CFP: 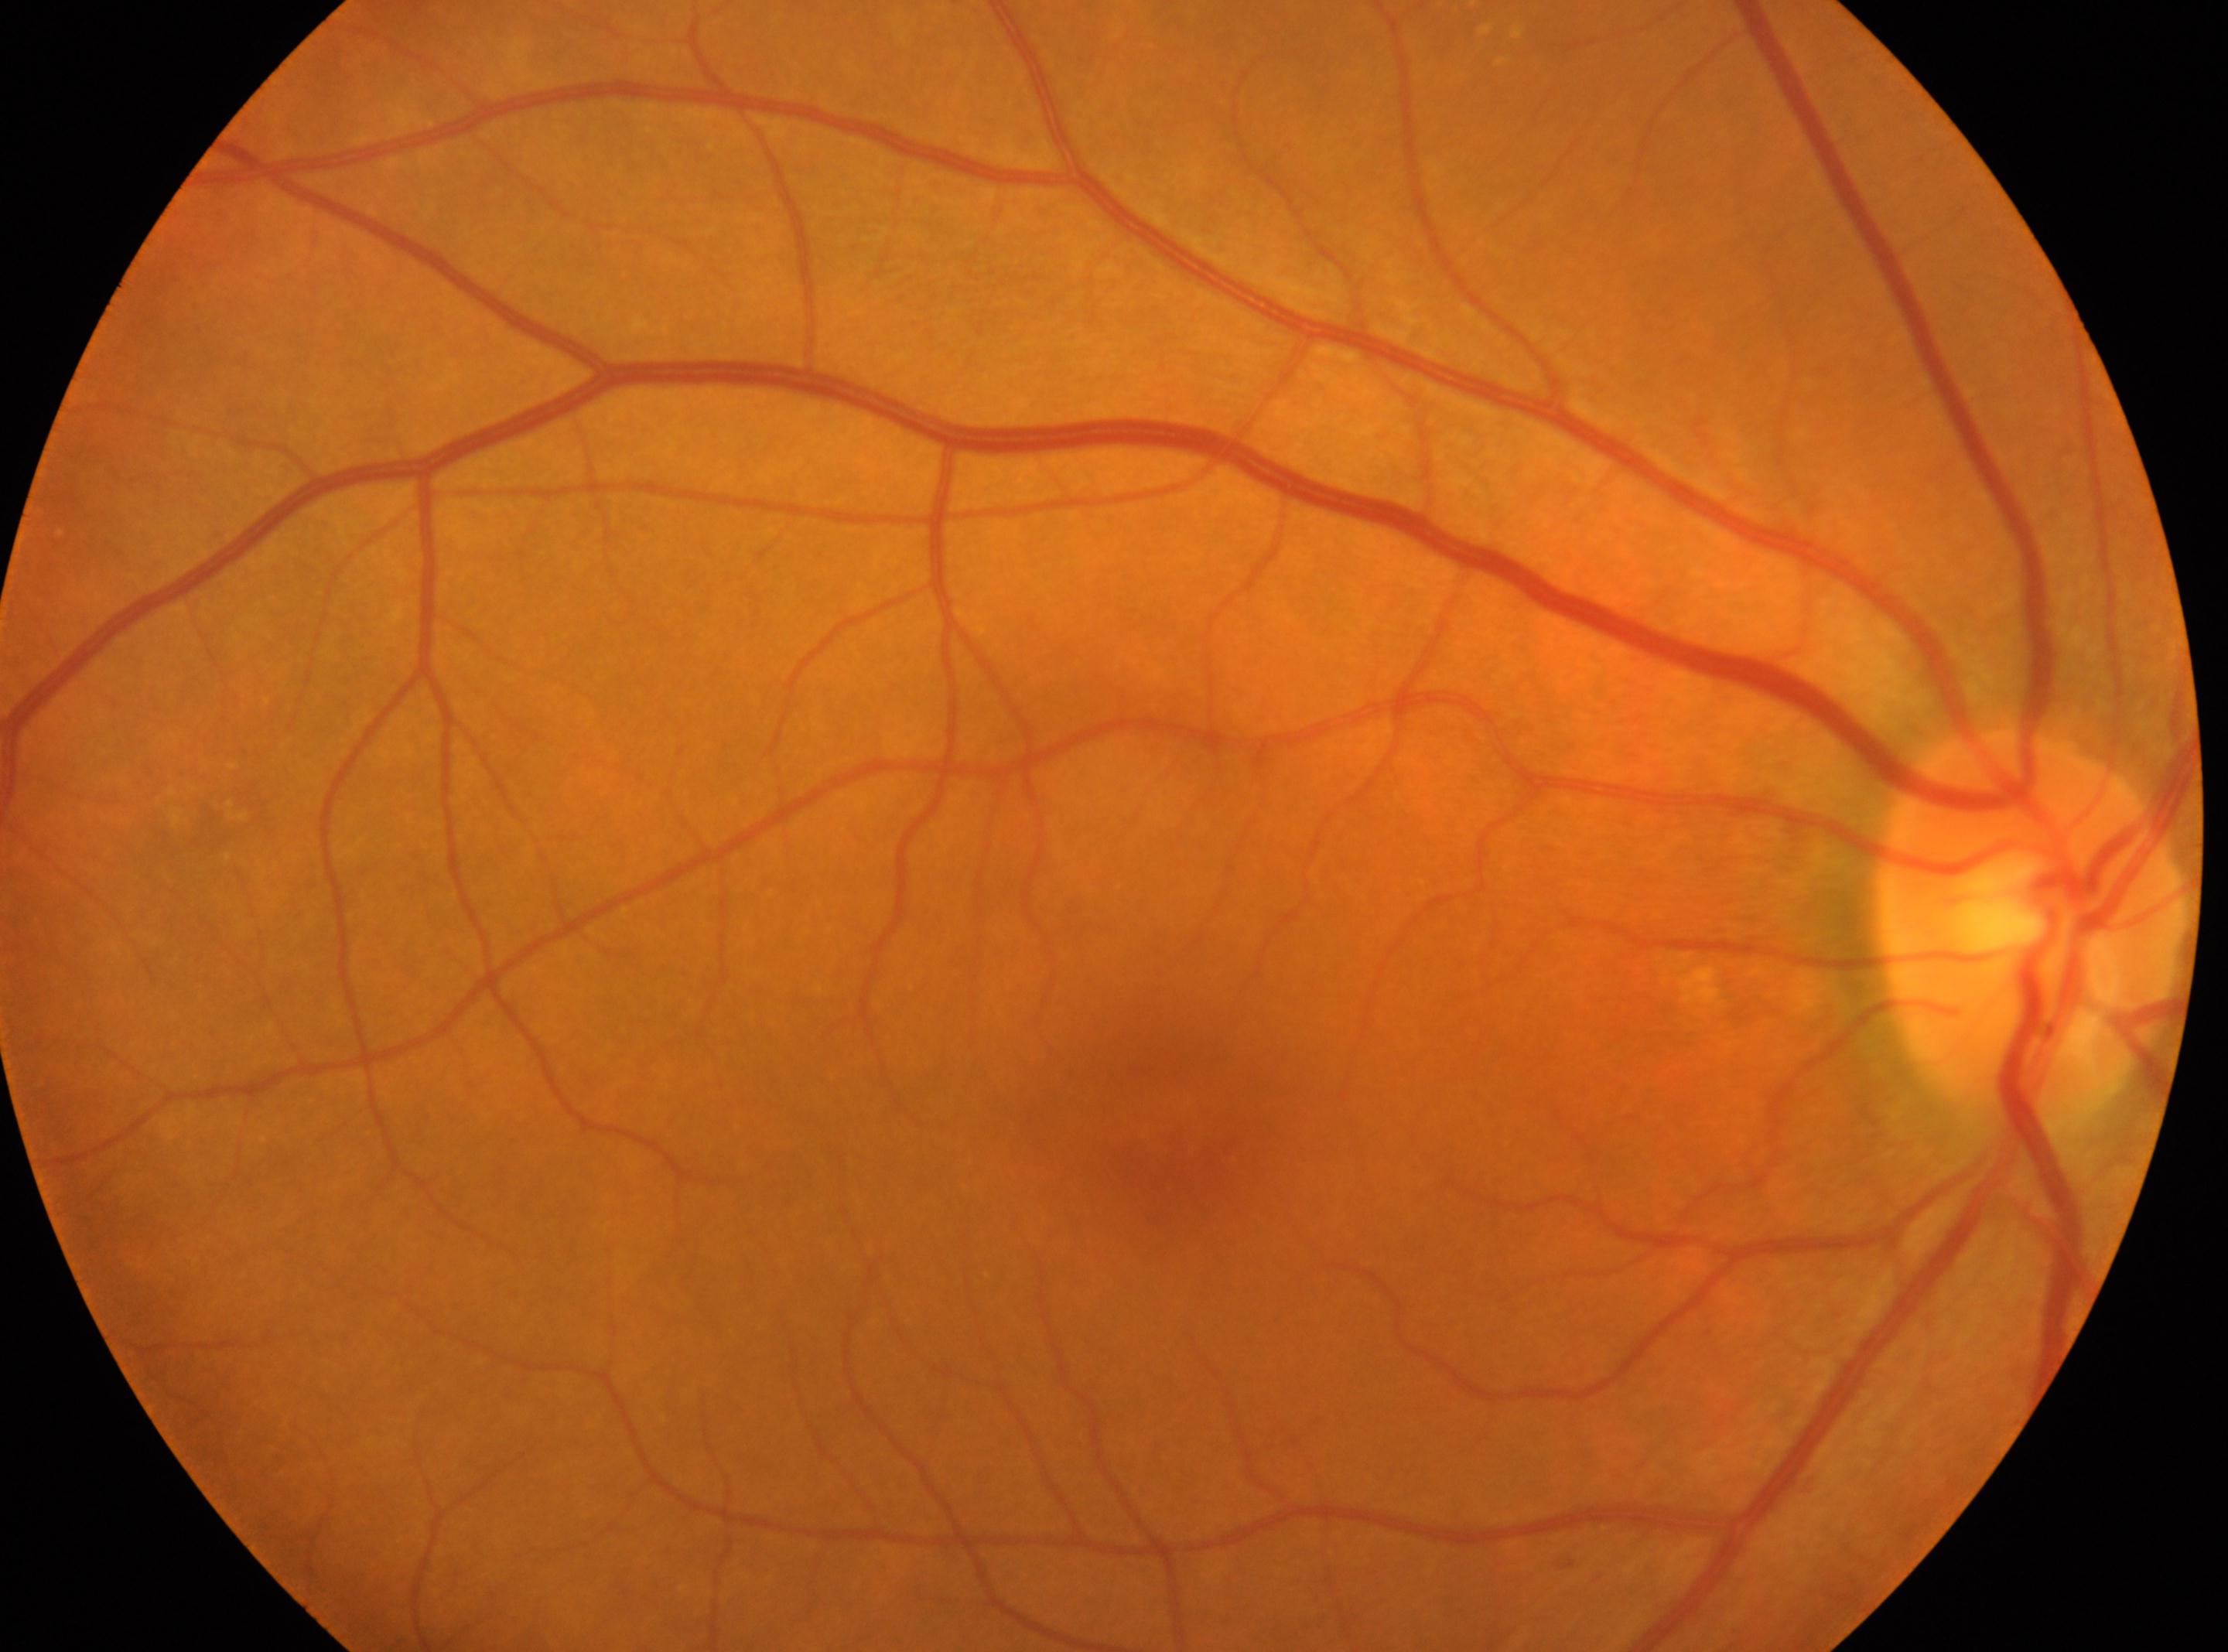

DR stage is grade 0 (no apparent retinopathy).
Optic disc: 2032px, 927px.
Eye: right.
The fovea centralis is at 1164px, 1132px.